2352x1568px; 45-degree field of view; retinal fundus photograph — 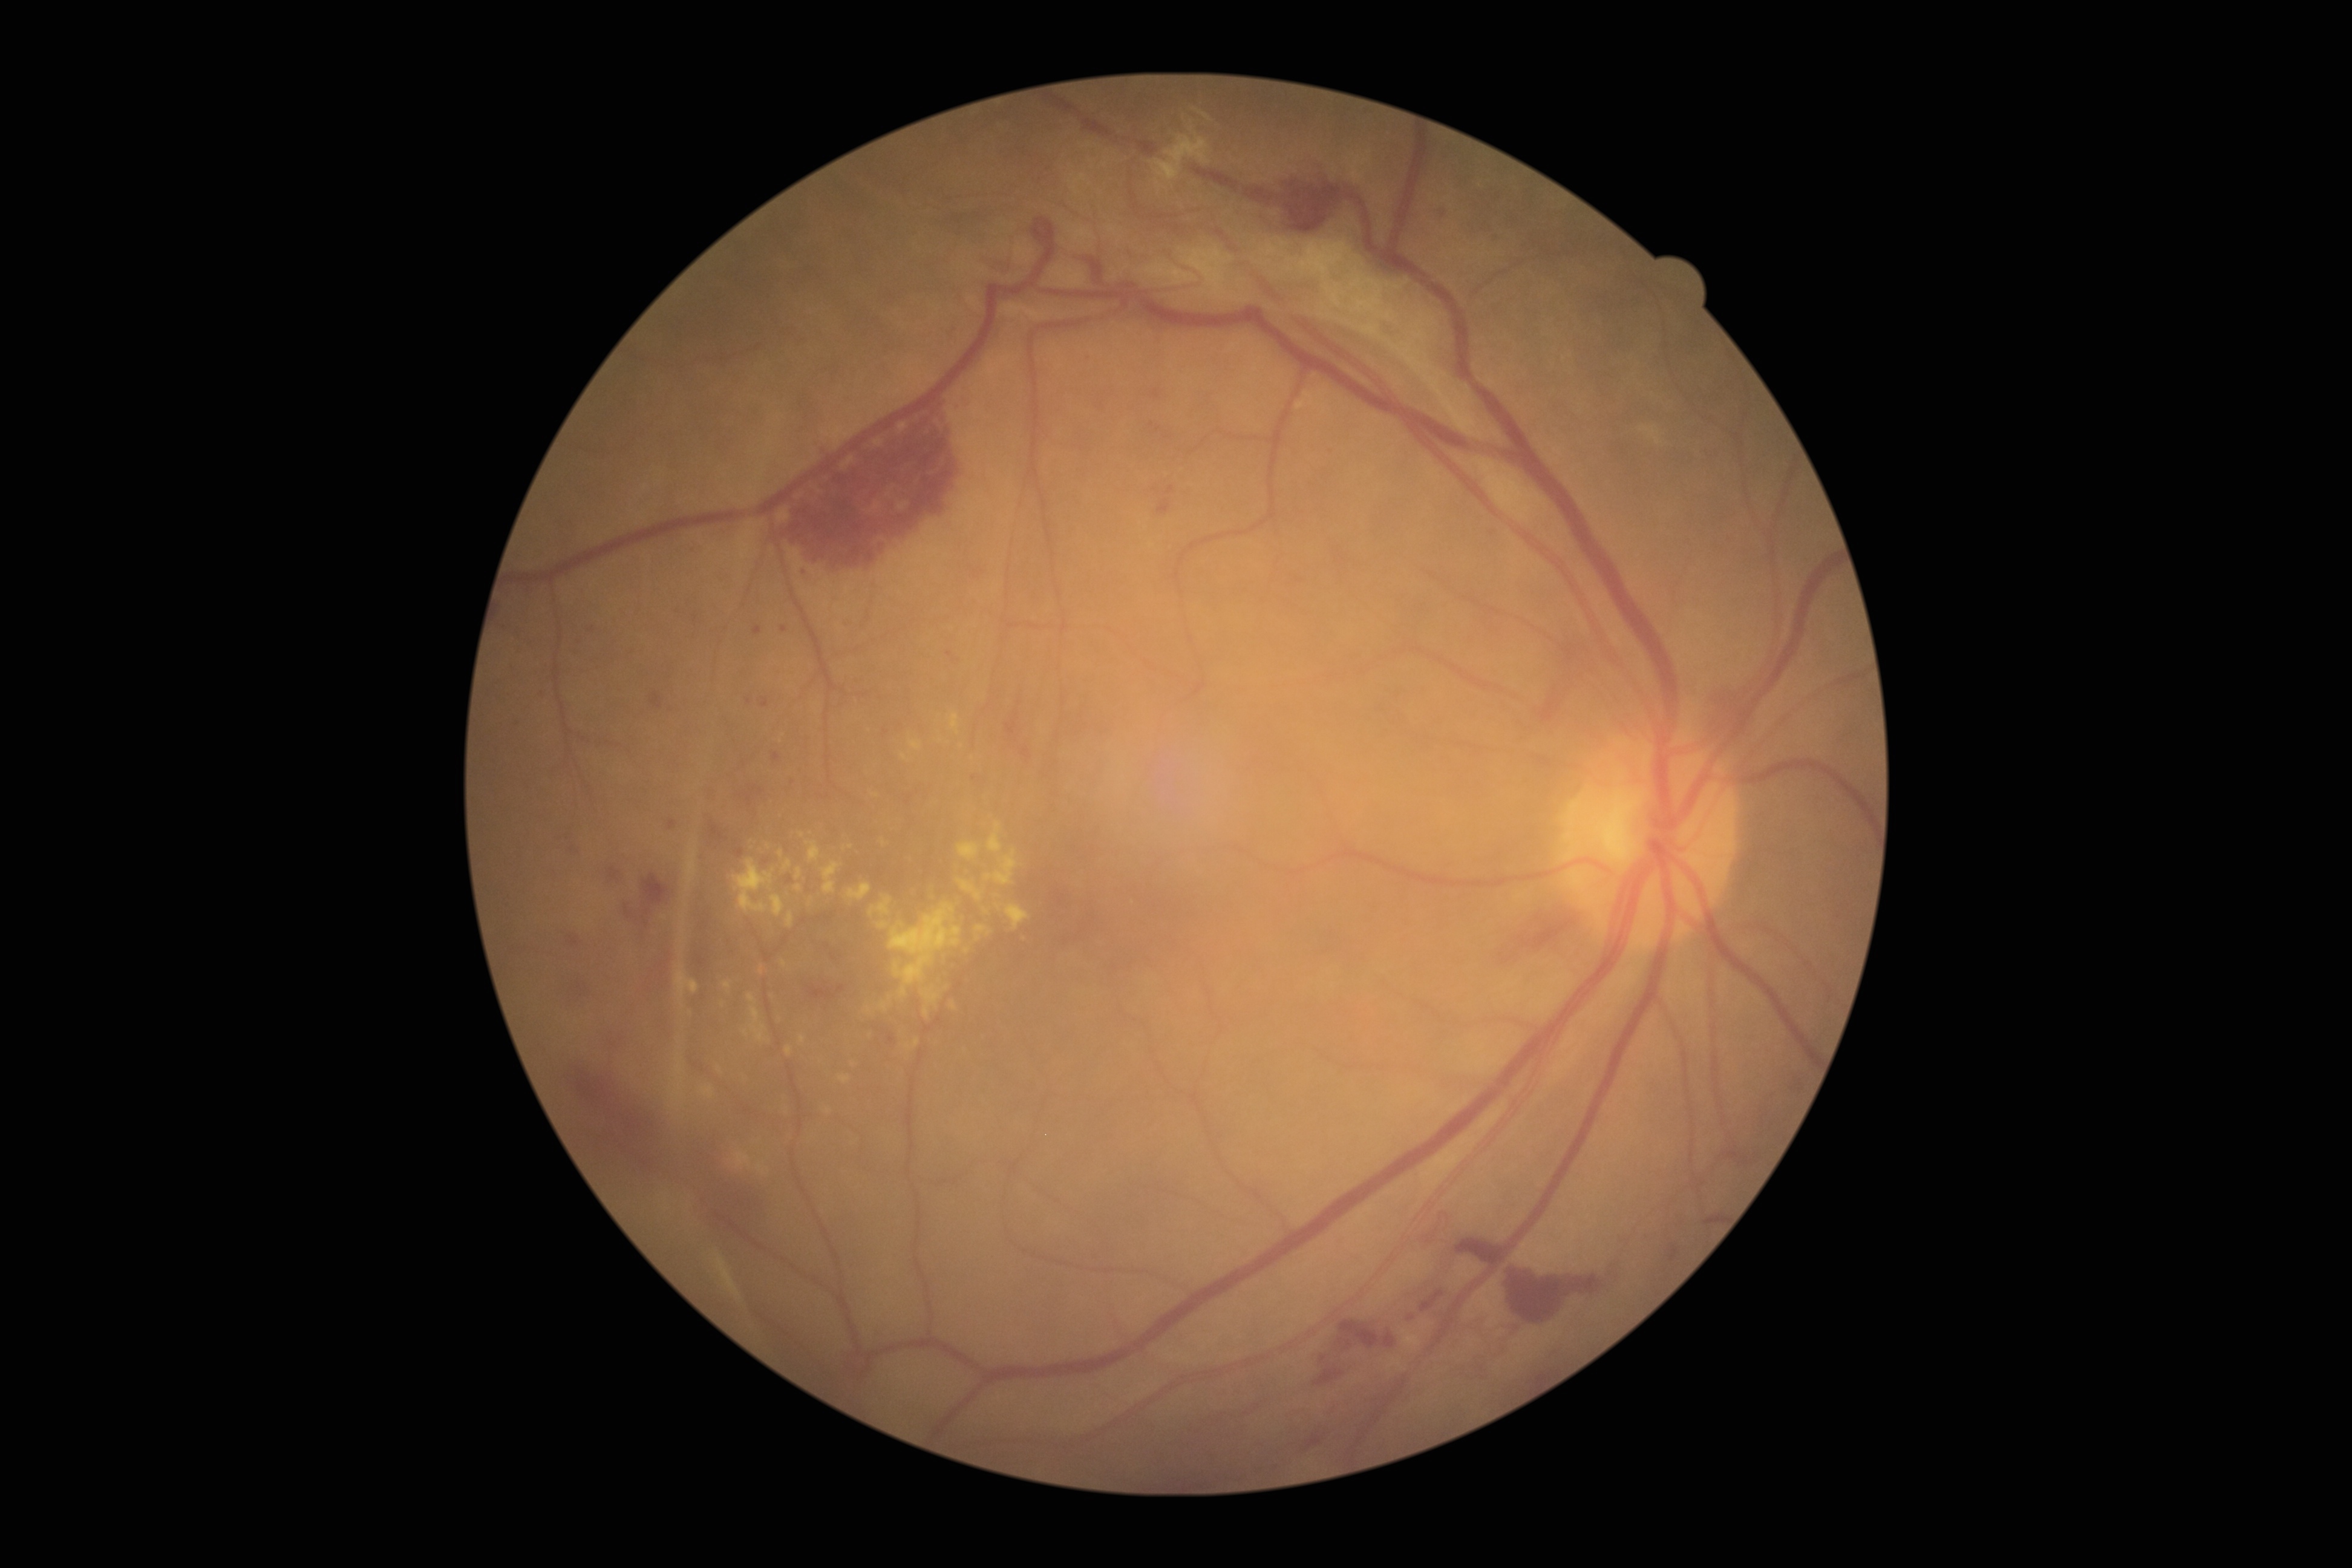

DR stage: PDR (grade 4)
A subset of detected lesions:
HEs (partial): l=1022, t=747, r=1031, b=759; l=1511, t=1275, r=1605, b=1321; l=624, t=874, r=668, b=924; l=1158, t=500, r=1171, b=516; l=1051, t=883, r=1073, b=924; l=1408, t=1313, r=1416, b=1321; l=1669, t=1246, r=1679, b=1260; l=1151, t=389, r=1160, b=400; l=1335, t=1321, r=1381, b=1350; l=809, t=987, r=835, b=1000; l=1420, t=1290, r=1445, b=1312; l=1492, t=913, r=1579, b=967; l=563, t=1058, r=660, b=1158; l=712, t=826, r=724, b=839; l=1319, t=1356, r=1327, b=1363; l=1383, t=1330, r=1397, b=1347
Small HEs near [581, 987]; [761, 791]
EXs (partial): l=748, t=994, r=768, b=1042; l=880, t=1002, r=887, b=1011; l=795, t=884, r=802, b=892; l=958, t=880, r=982, b=901; l=976, t=926, r=987, b=932; l=909, t=740, r=921, b=751; l=806, t=840, r=820, b=862; l=734, t=858, r=775, b=913; l=871, t=896, r=892, b=916; l=878, t=921, r=890, b=930; l=913, t=1039, r=920, b=1048; l=950, t=713, r=961, b=735
Small EXs near [829, 1111]; [745, 1032]; [908, 1047]; [852, 847]